Retinal fundus photograph, 1932x1932, 45° FOV — 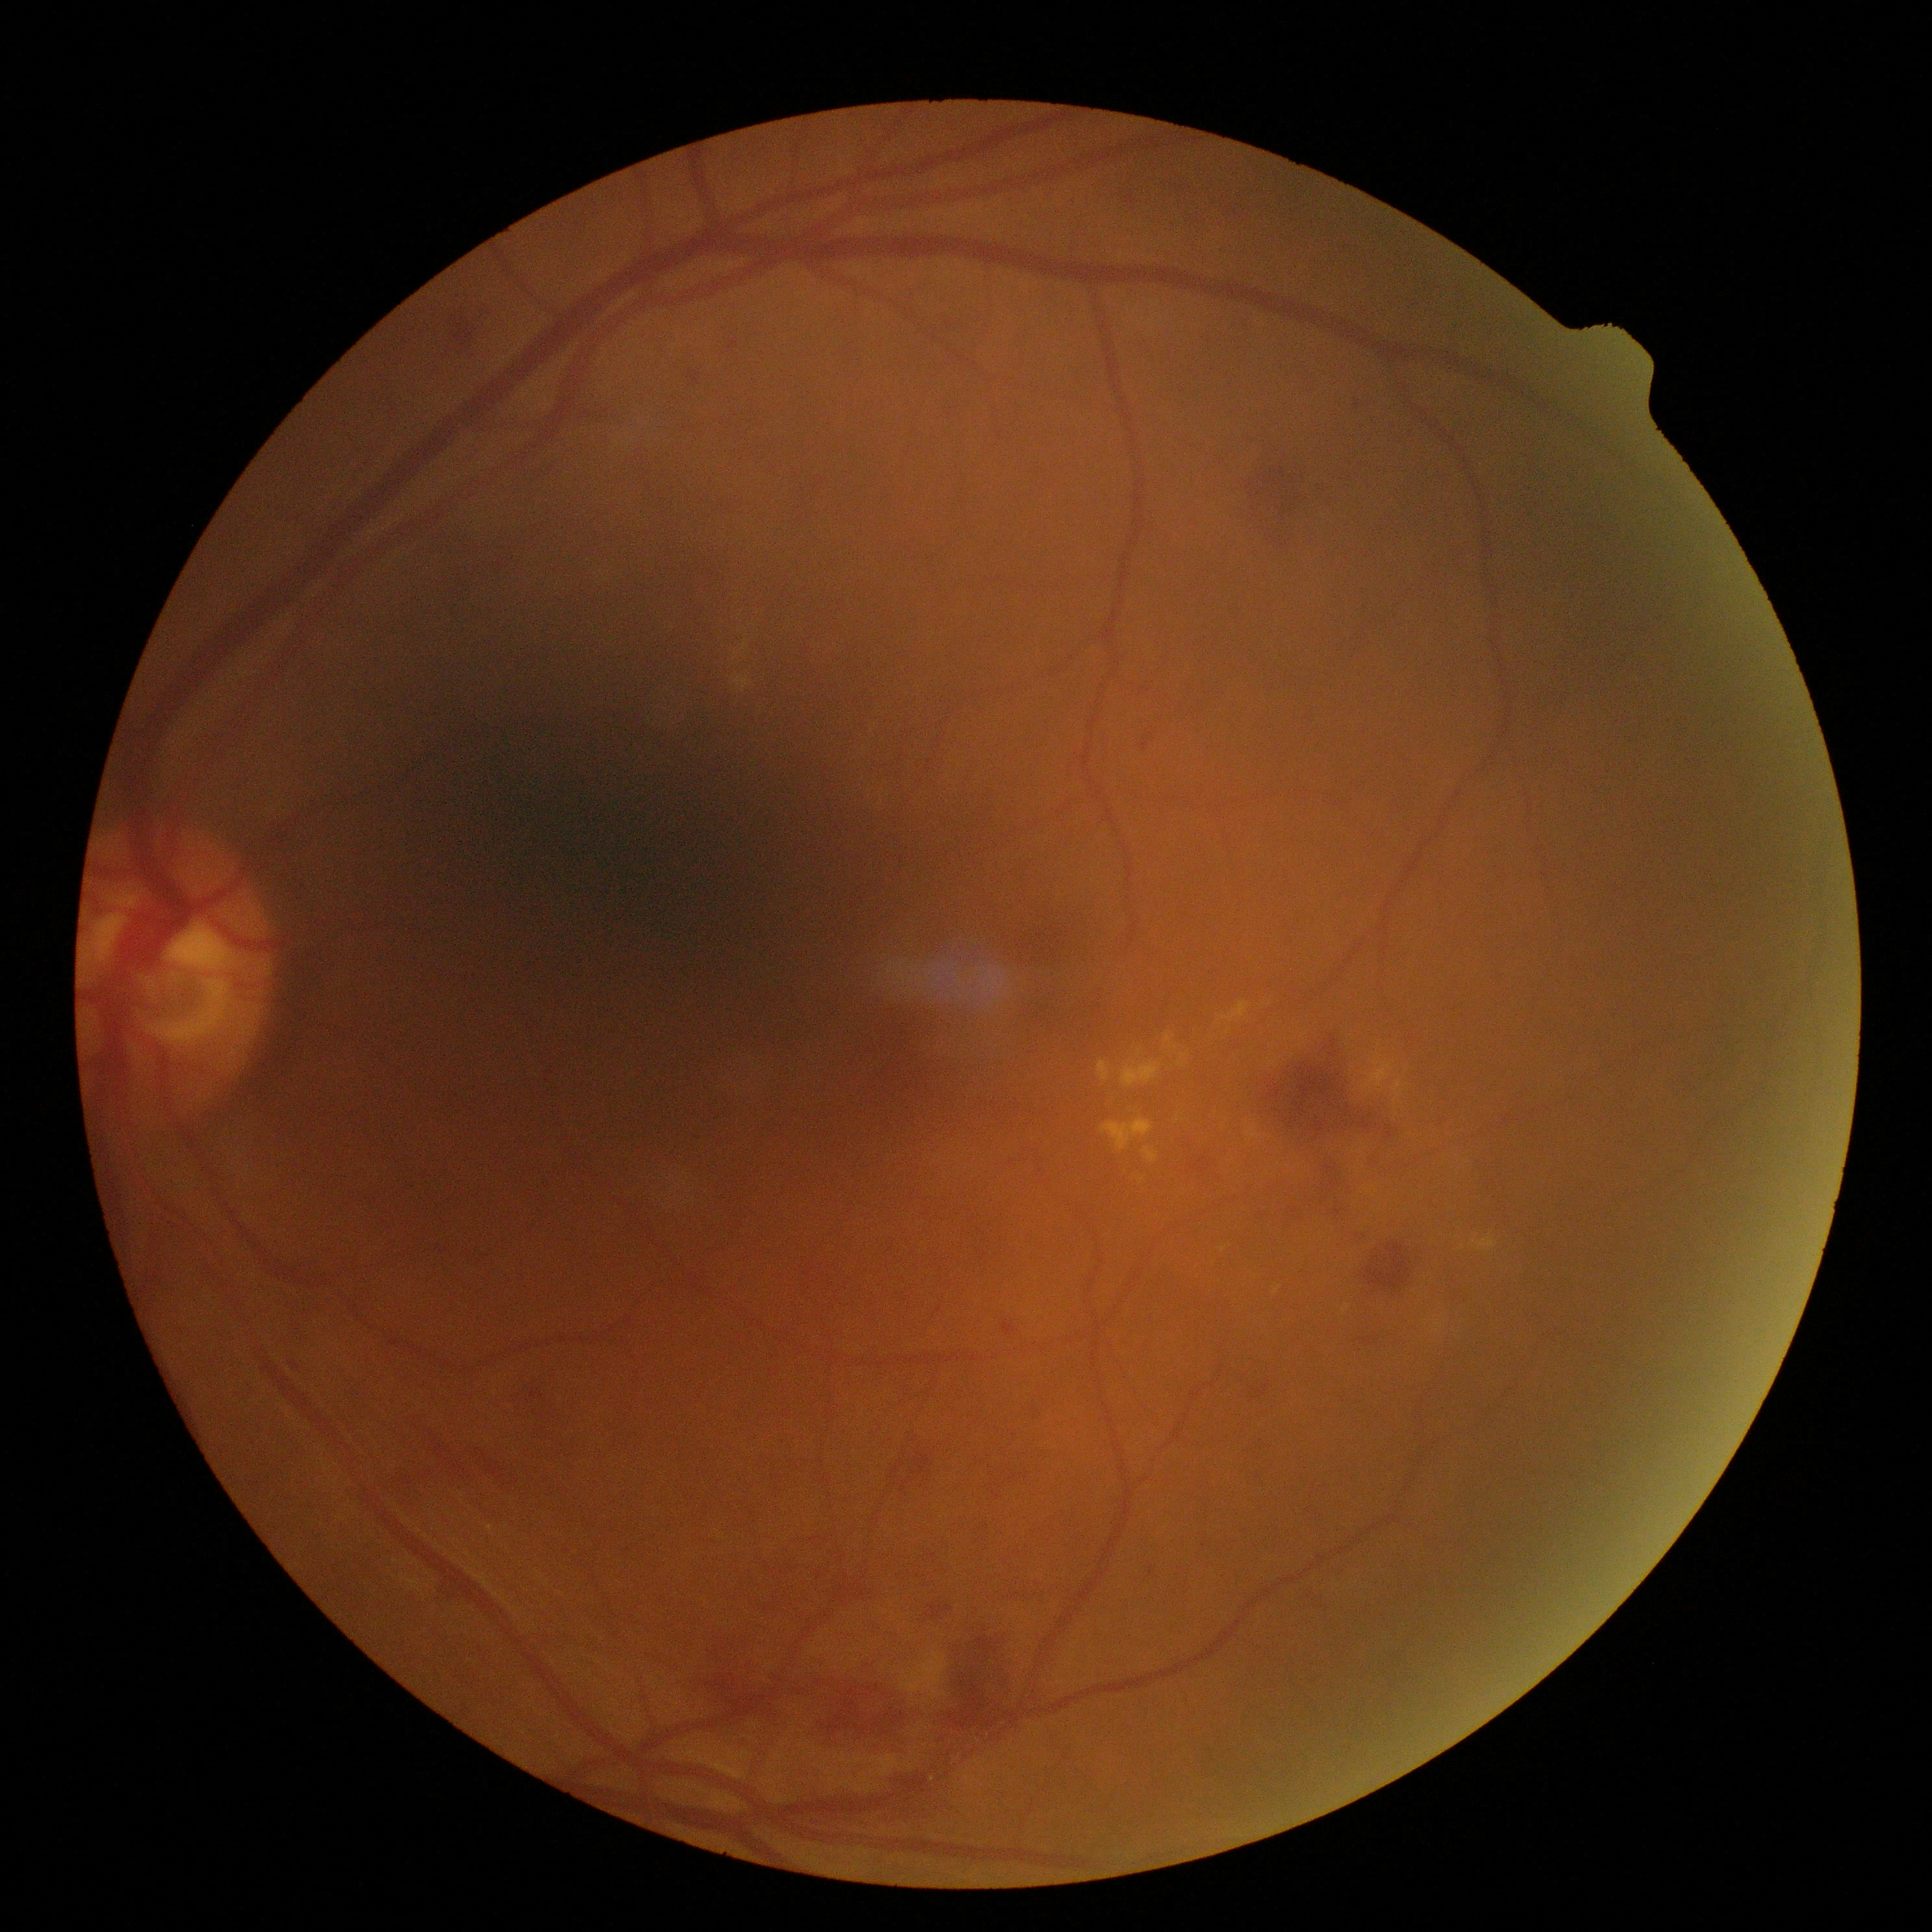
Retinopathy: grade 2 (moderate NPDR) — more than just microaneurysms but less than severe NPDR.
The retinopathy is classified as non-proliferative diabetic retinopathy.